ONH-centered crop from a color fundus image; 364 by 364 pixels; captured with pupil dilation:
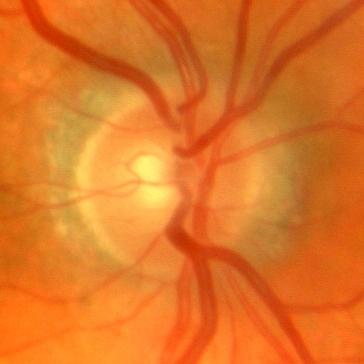
No glaucomatous changes.